2212 by 1659 pixels · color fundus image: 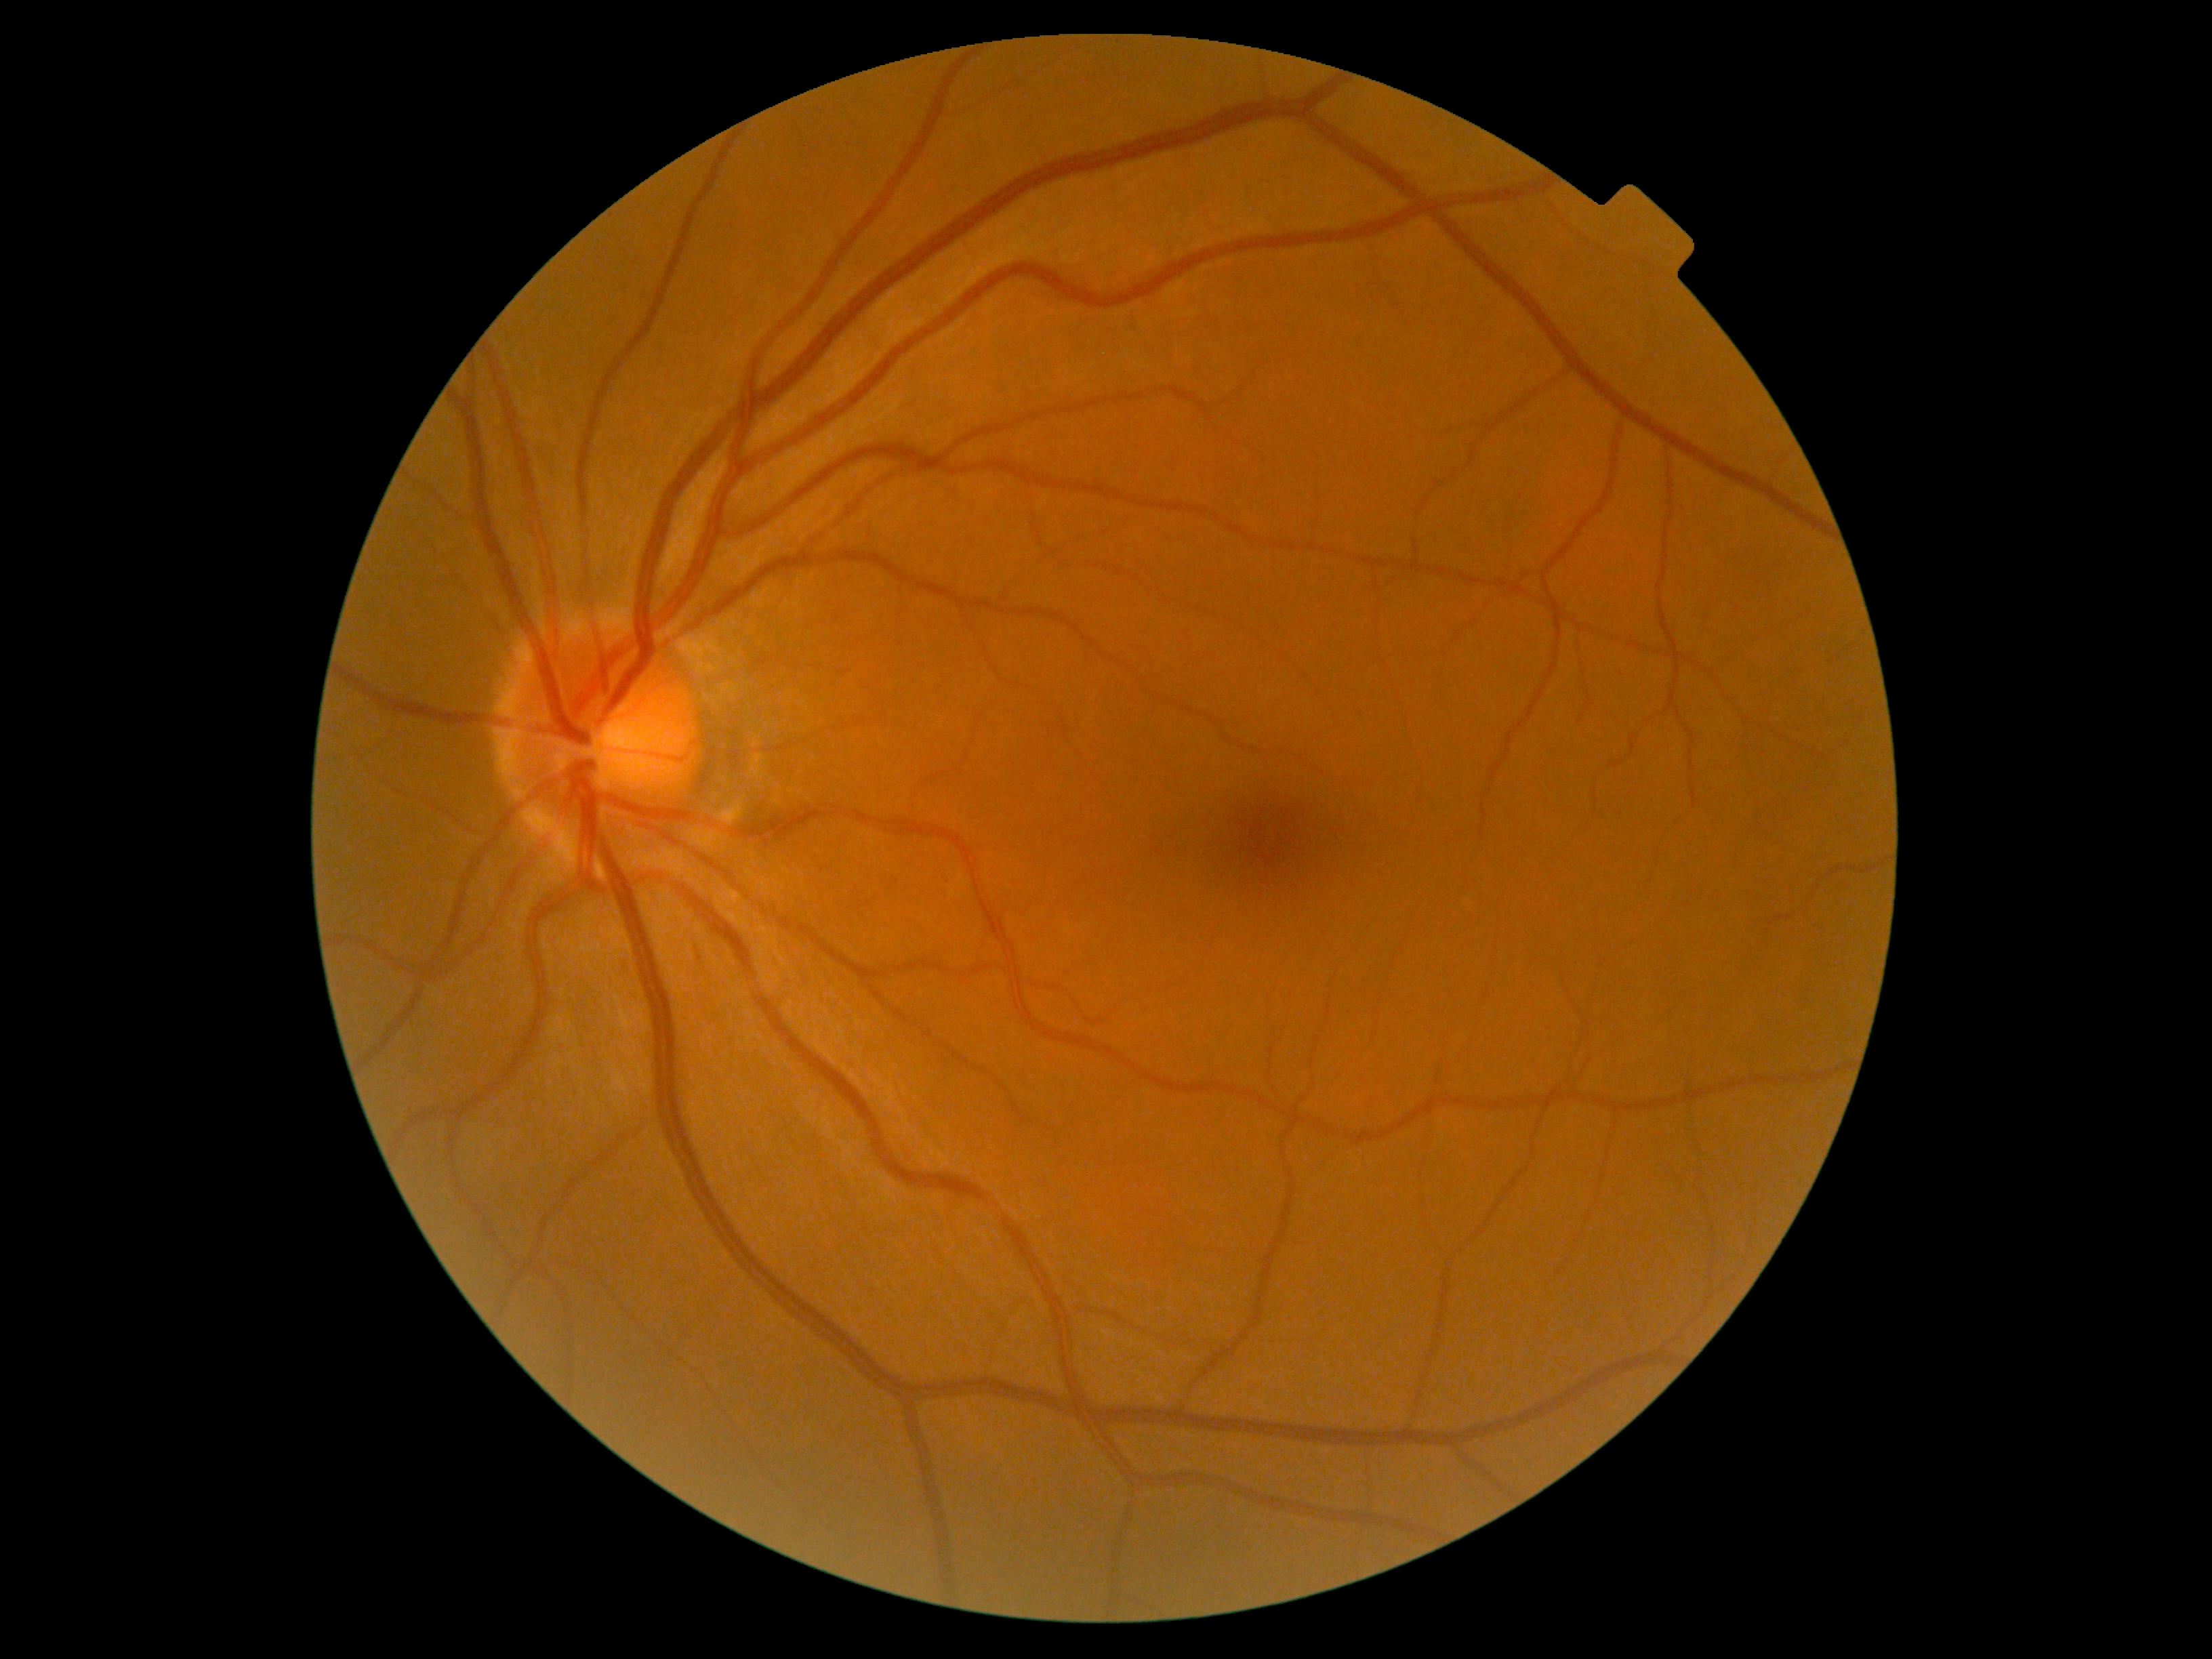 Diabetic retinopathy severity is 0.